Optic nerve head crop; acquired with a Nidek AFC-330
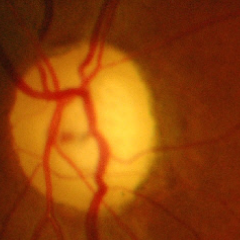
Optic disc photograph demonstrating severe glaucomatous damage.